2048 x 1536 pixels.
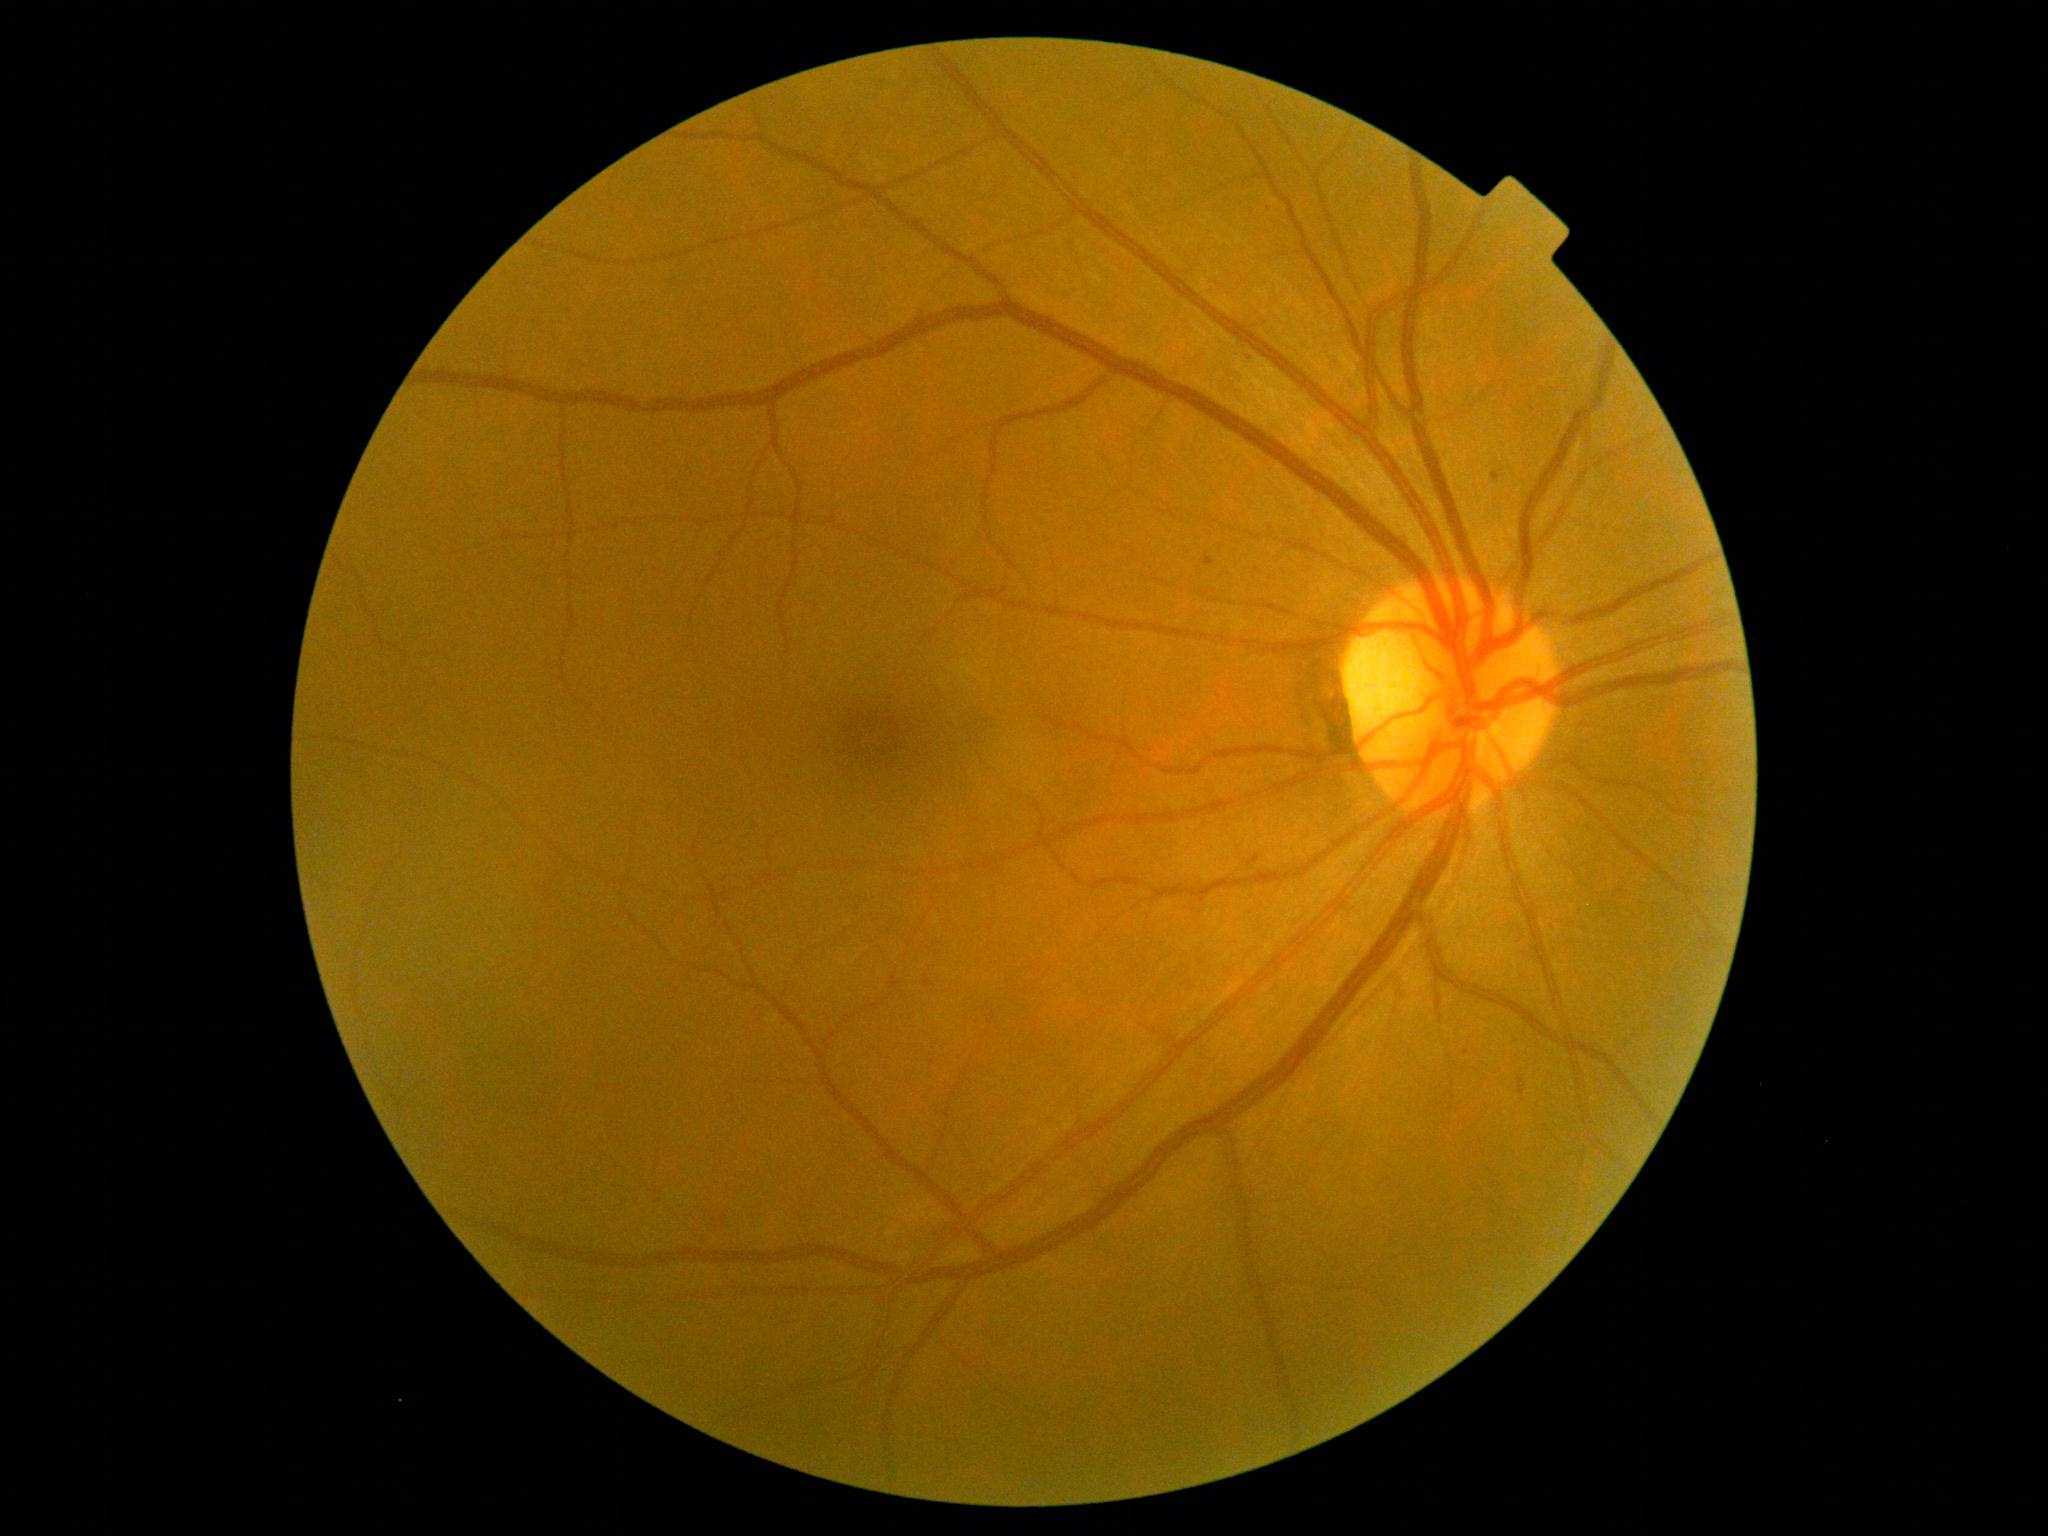

dr_grade: grade 1